Image size 848x848, FOV: 45 degrees, acquired with a NIDEK AFC-230, color fundus photograph — 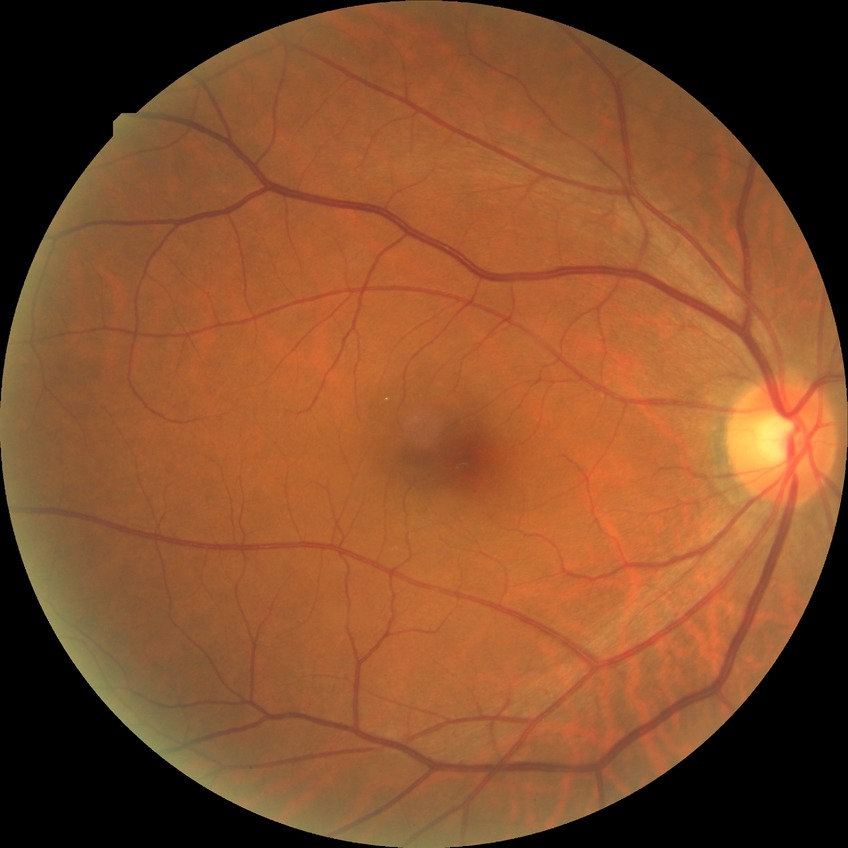
{
  "davis_grade": "no diabetic retinopathy (NDR)"
}